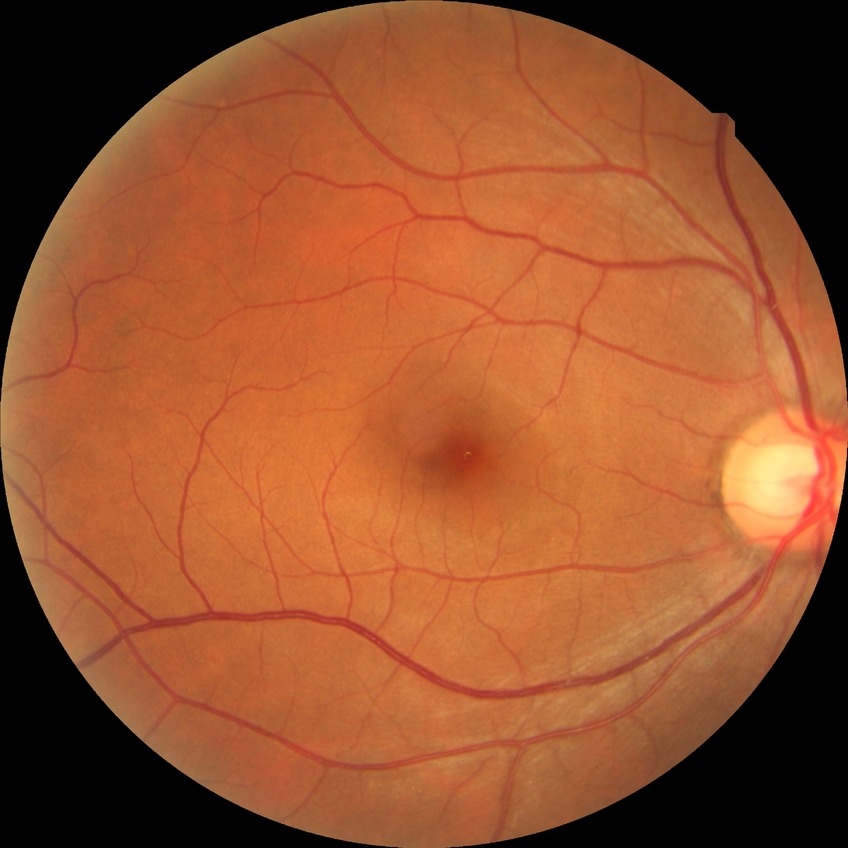 Modified Davis classification is no diabetic retinopathy.